Camera: NIDEK AFC-230, color fundus photograph, 848 by 848 pixels, modified Davis classification, without pupil dilation:
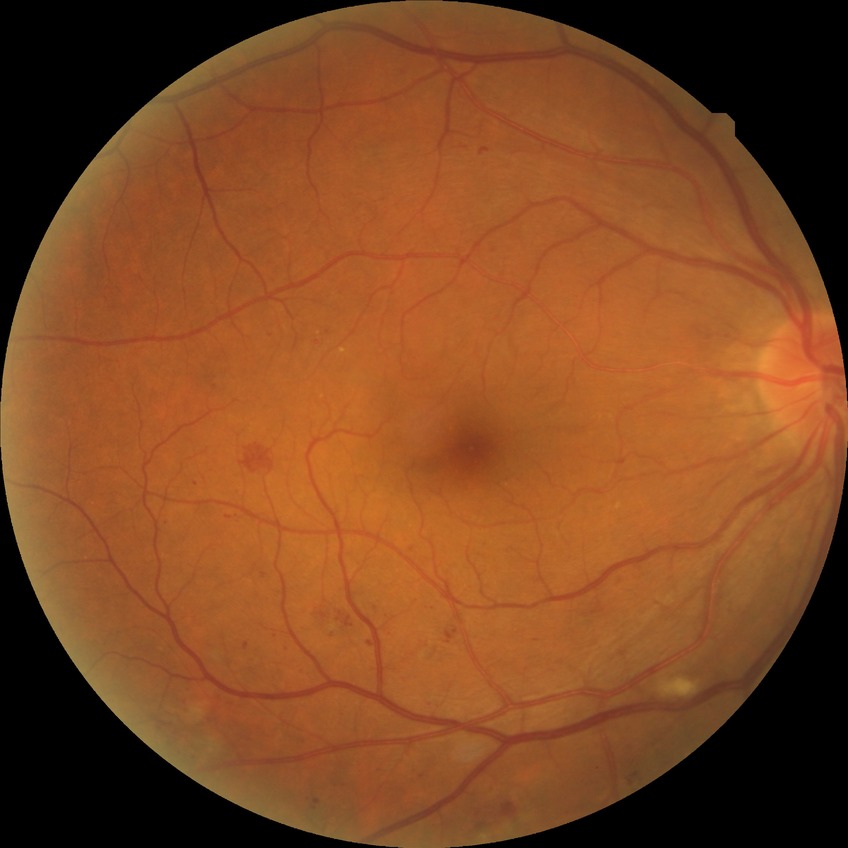
Diabetic retinopathy (DR): simple diabetic retinopathy (SDR).